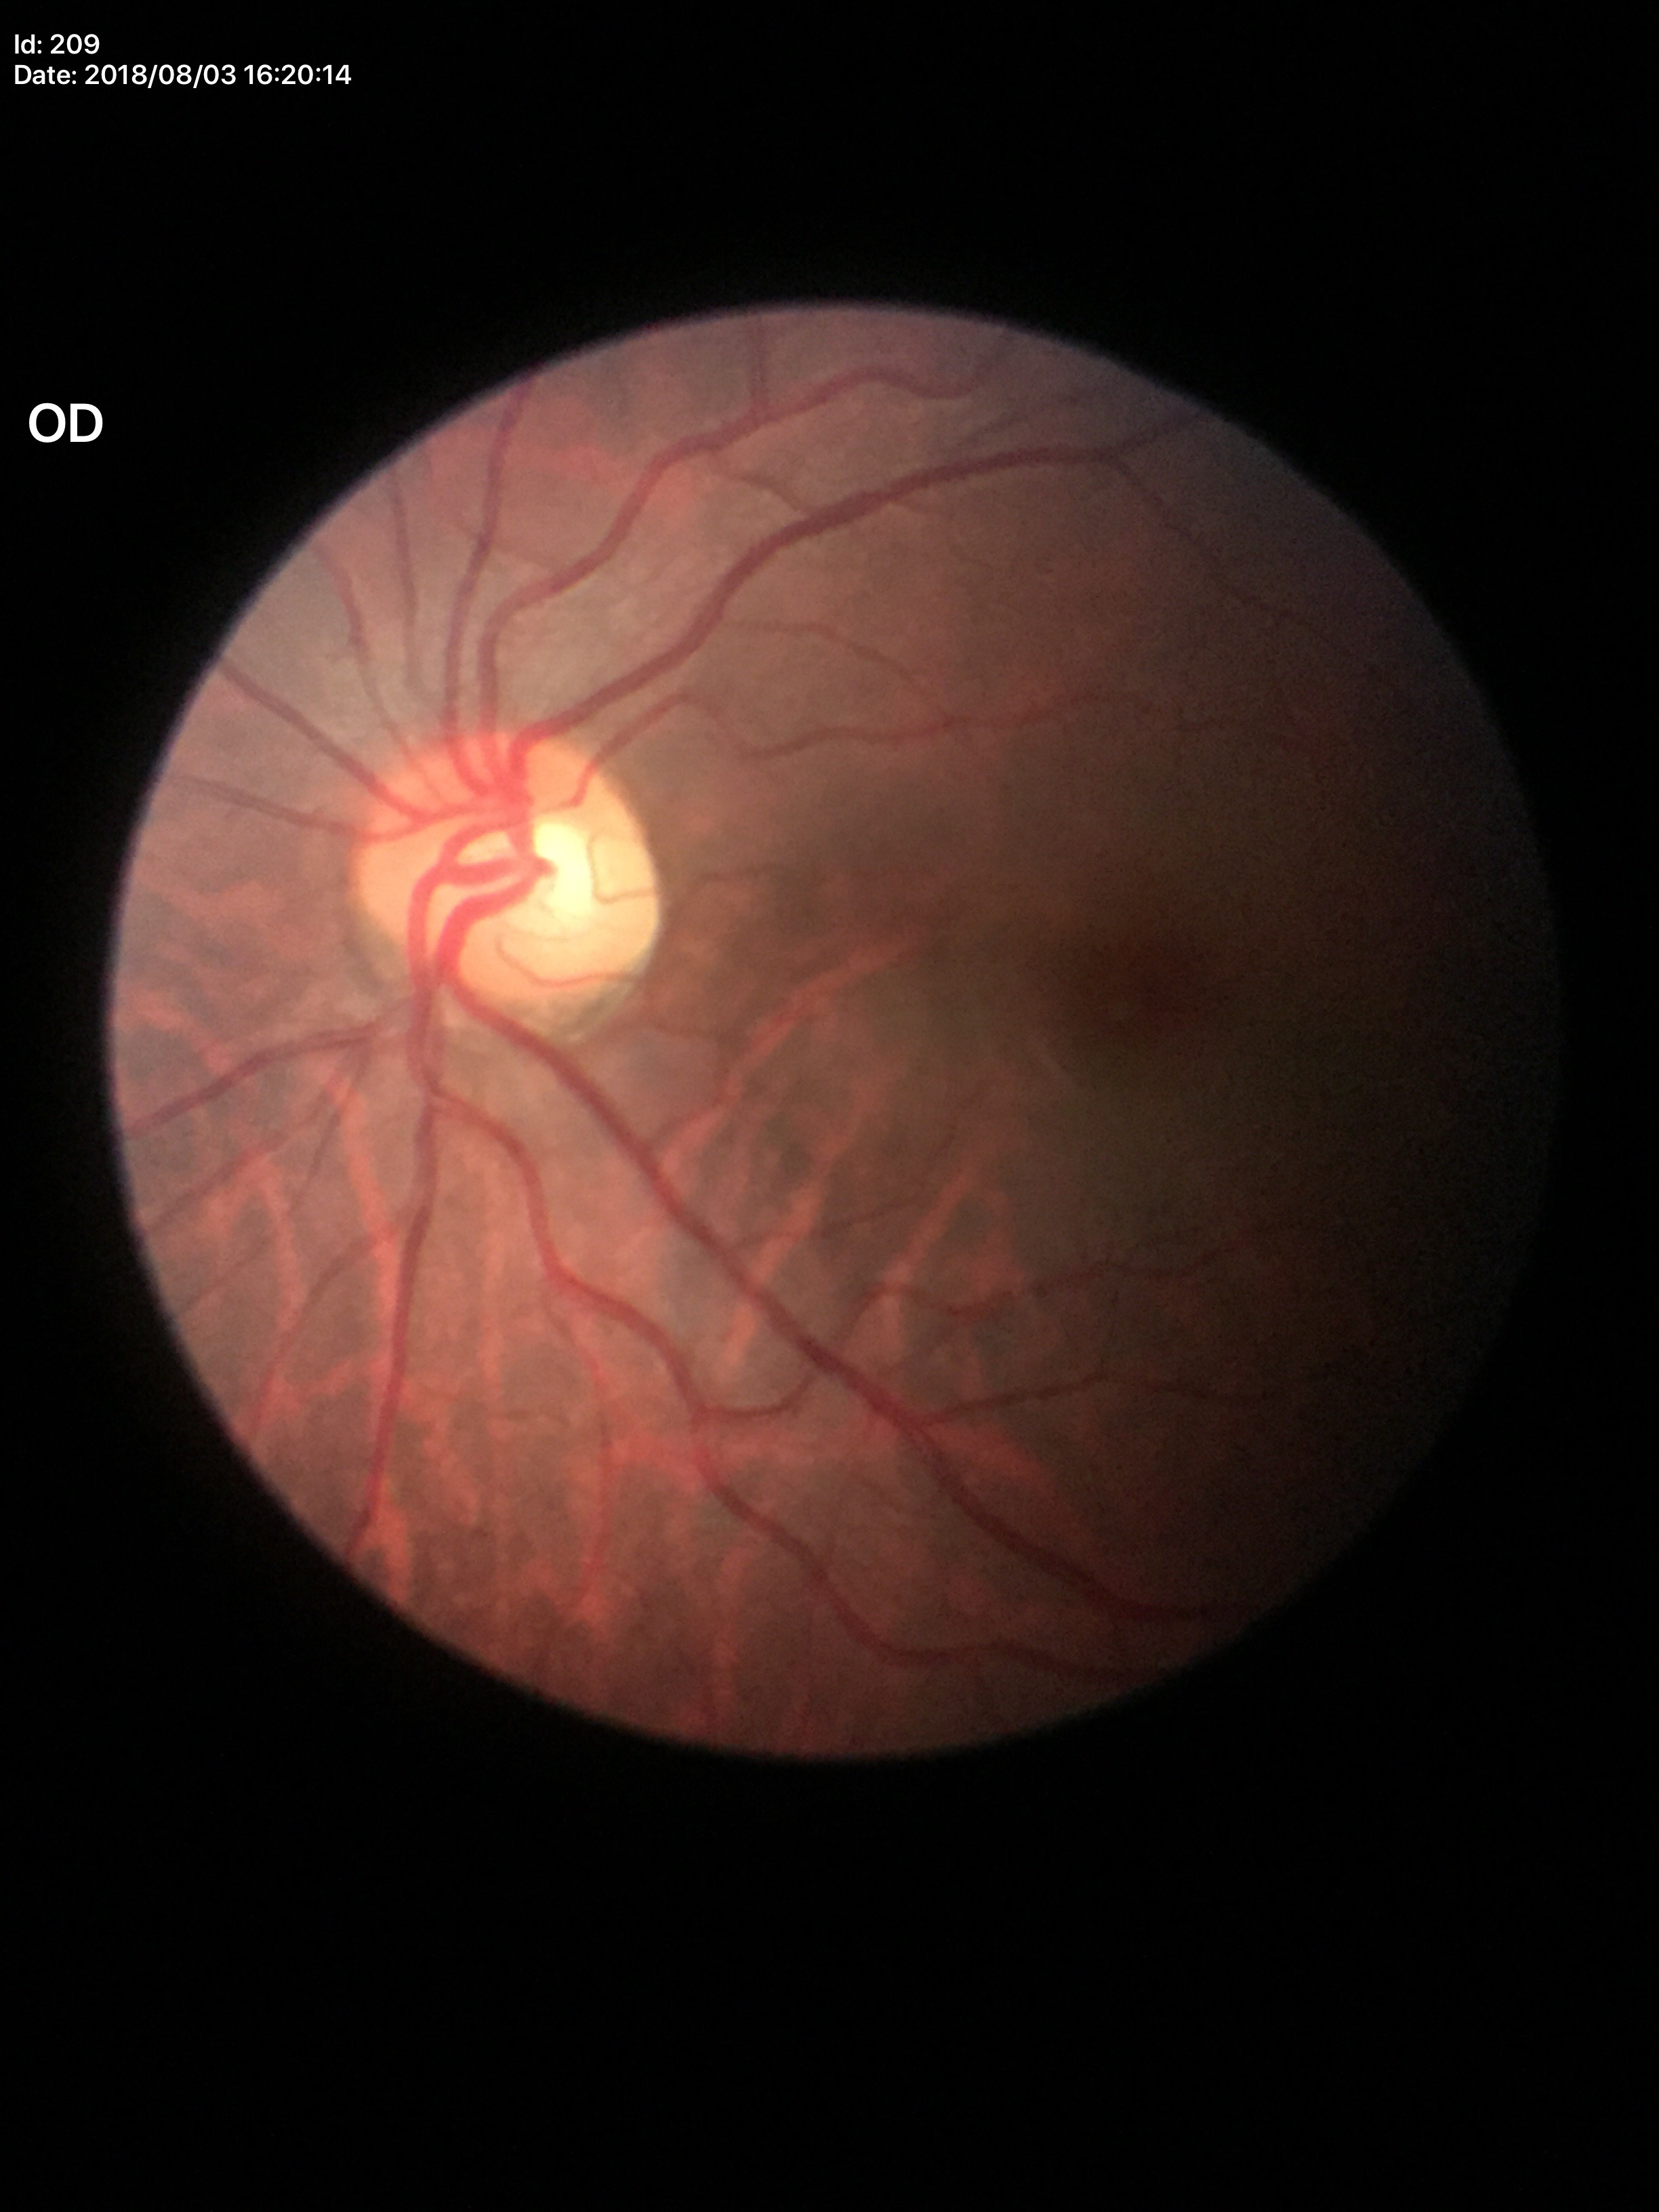
area C/D ratio=0.24; Glaucoma decision=no suspicious findings; horizontal cup-to-disc ratio=0.48; vertical cup-disc ratio=0.49